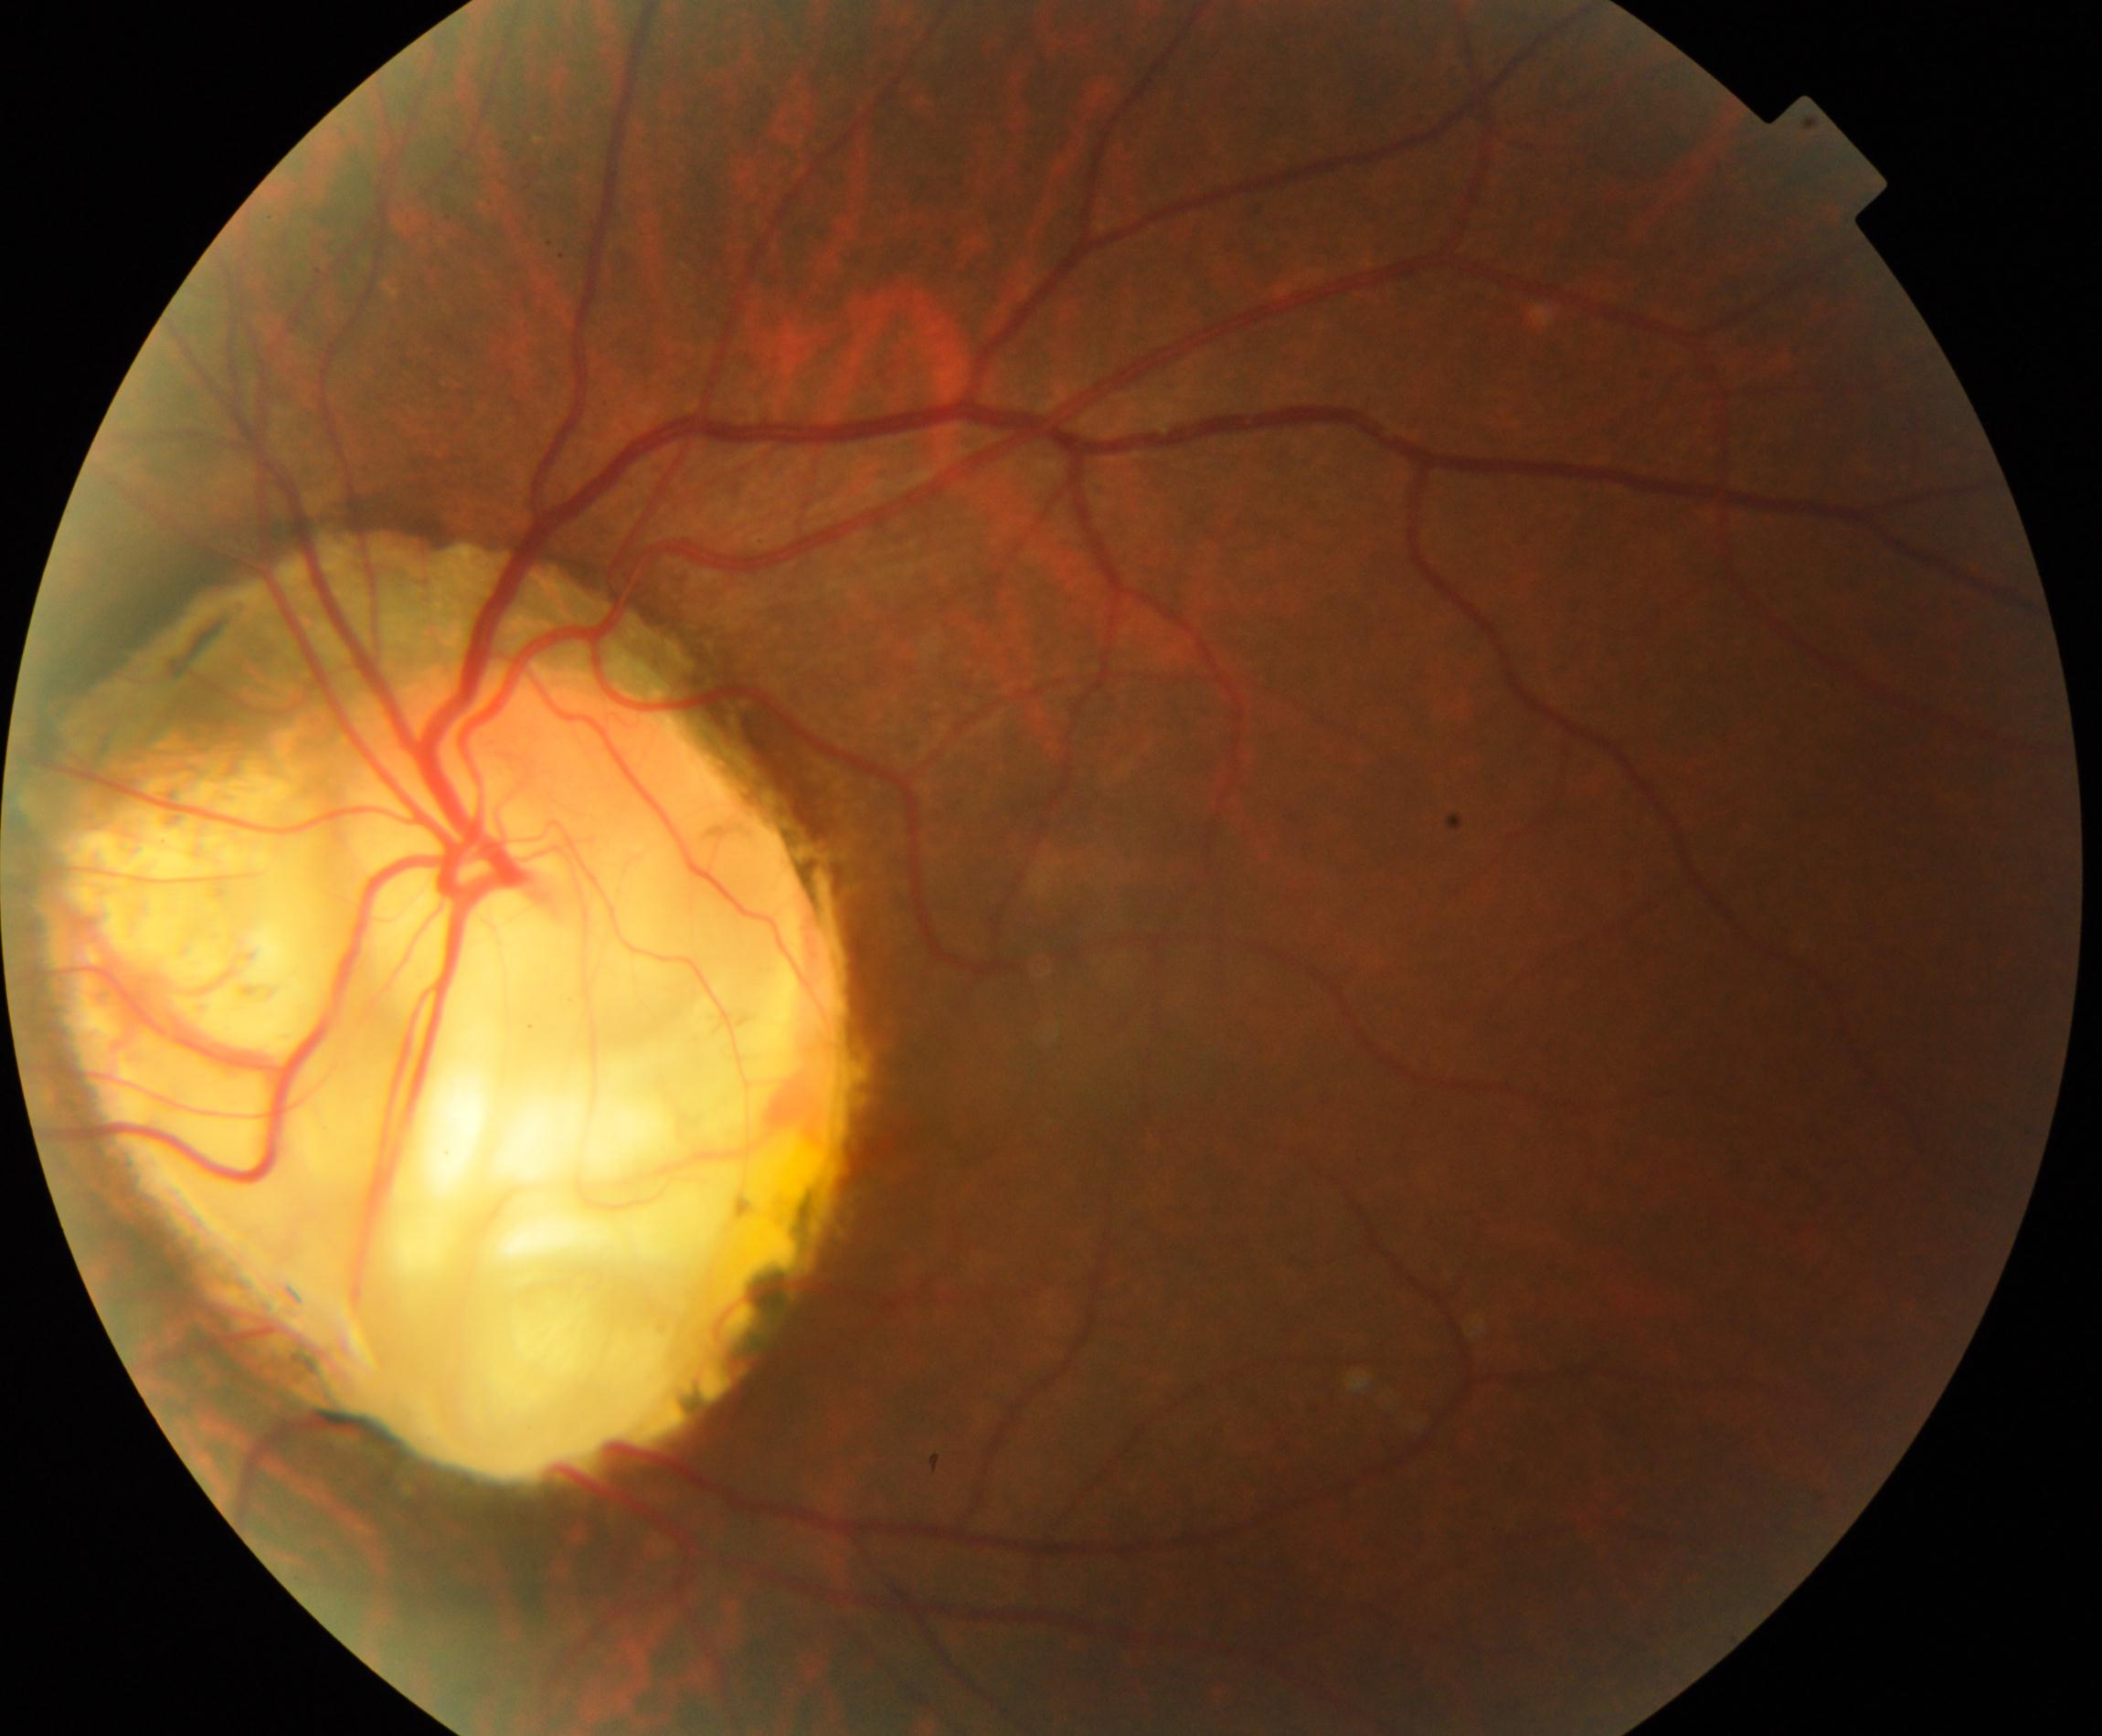 Retinal fundus photograph demonstrating congenital disc abnormality. Defined by optic disc coloboma, morning glory anomaly, optic pit, megalopapilla, or hypoplastic disc.